Pediatric wide-field fundus photograph — 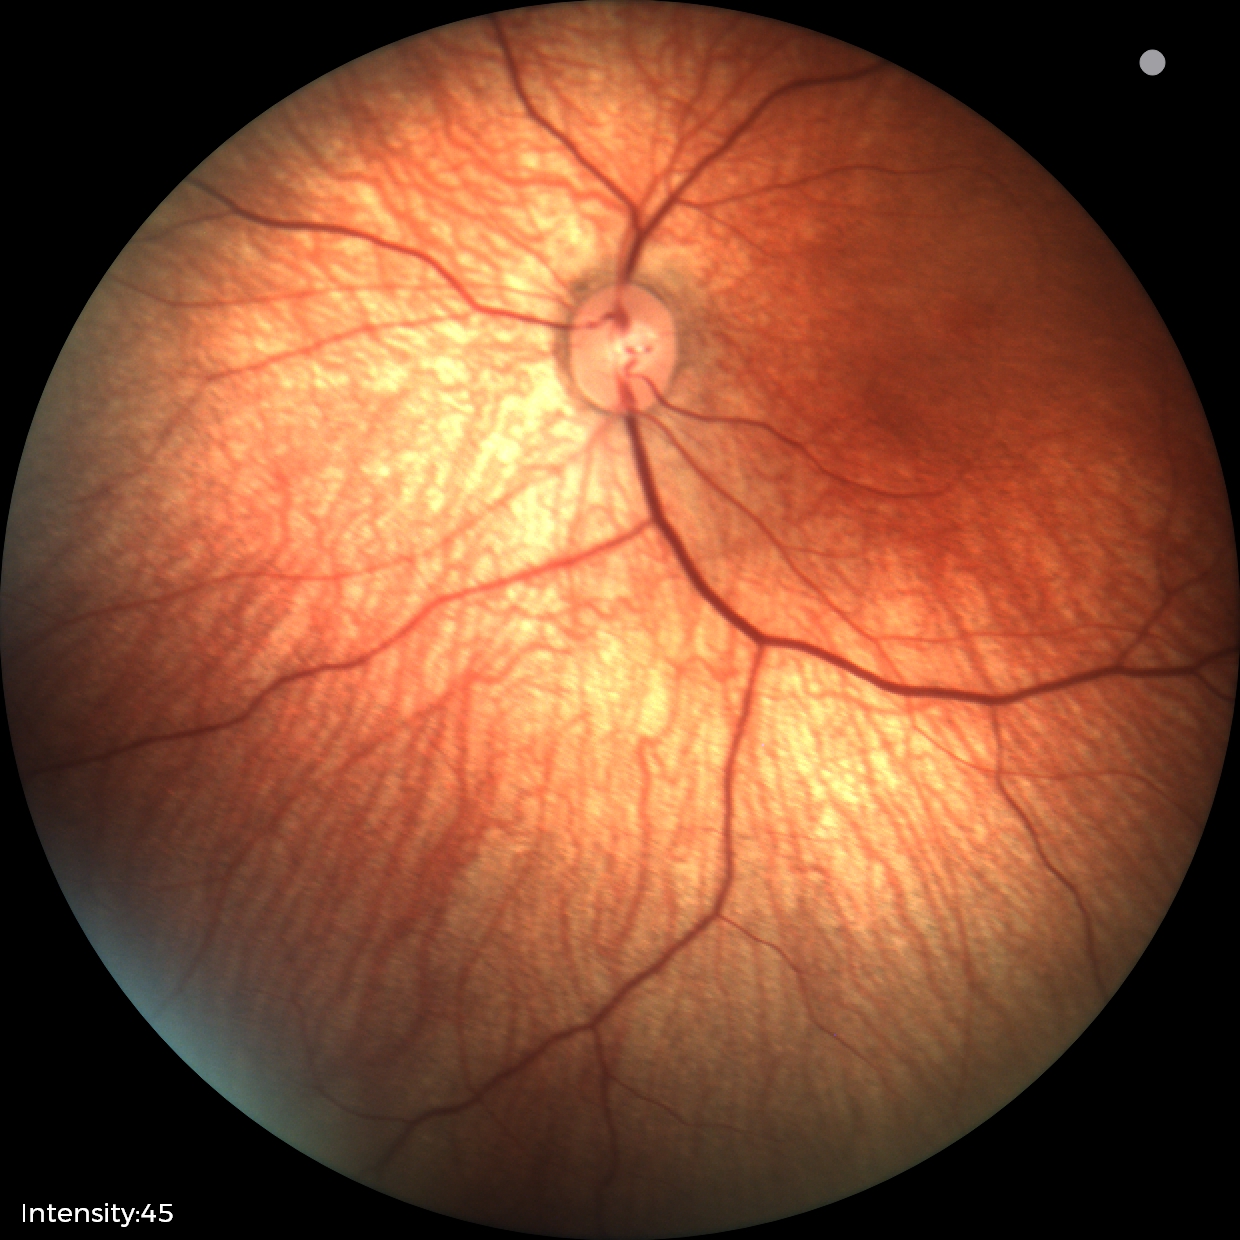 Screening examination diagnosed as physiological.